Pediatric wide-field fundus photograph
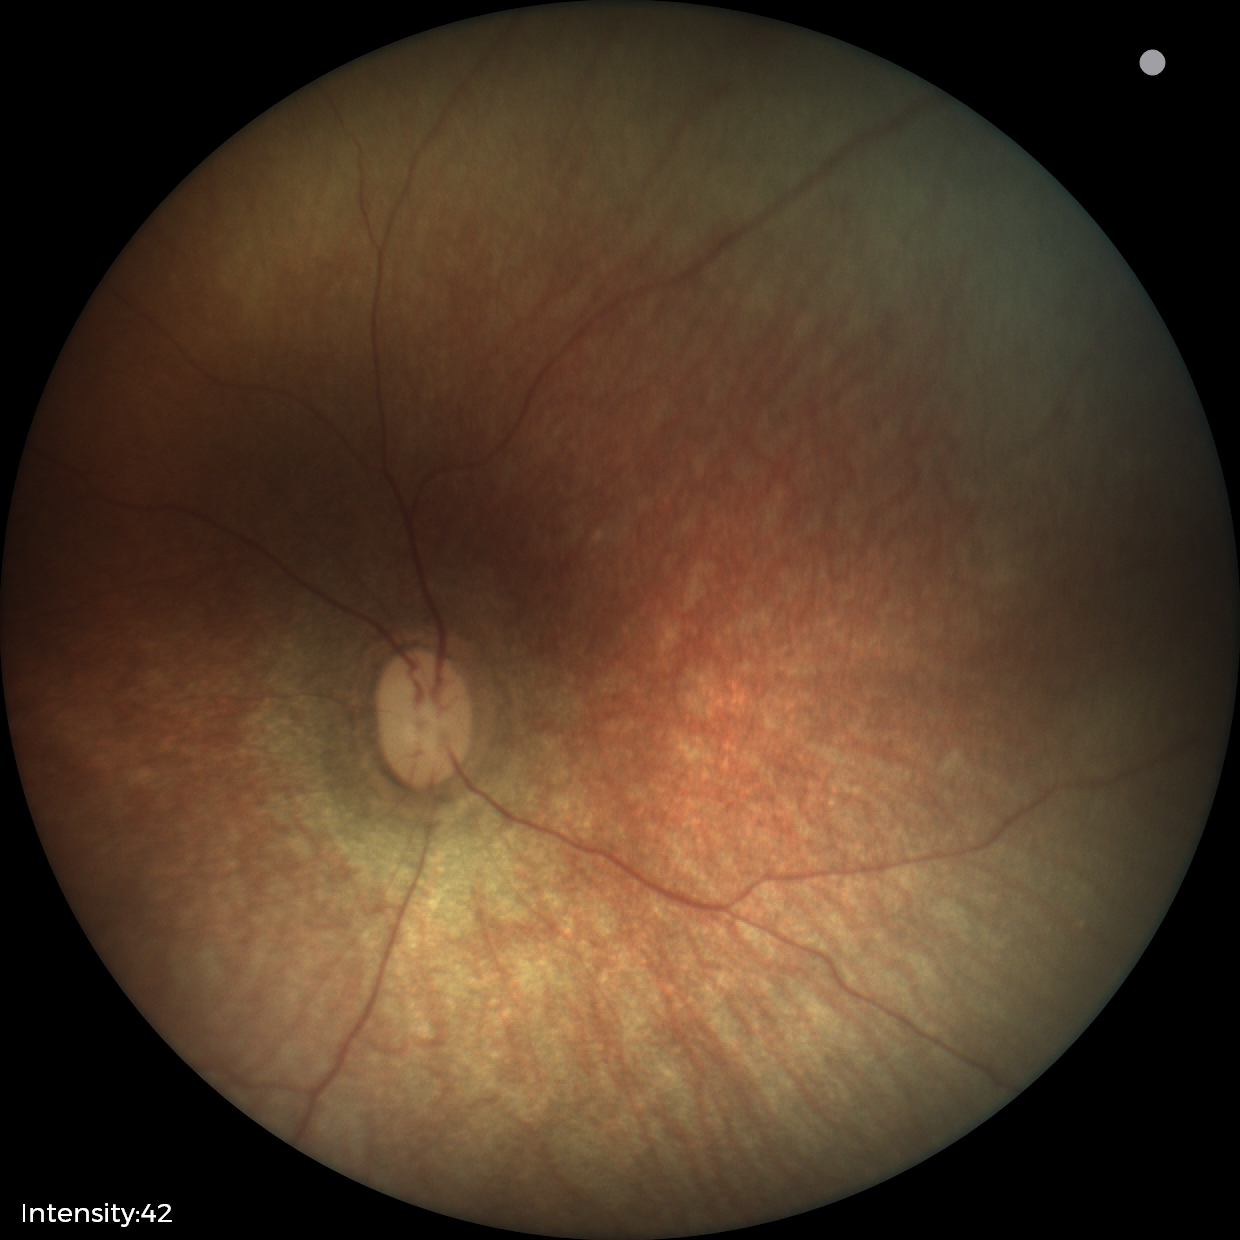
Physiological retinal appearance for postconceptual age.